Retinal fundus photograph:
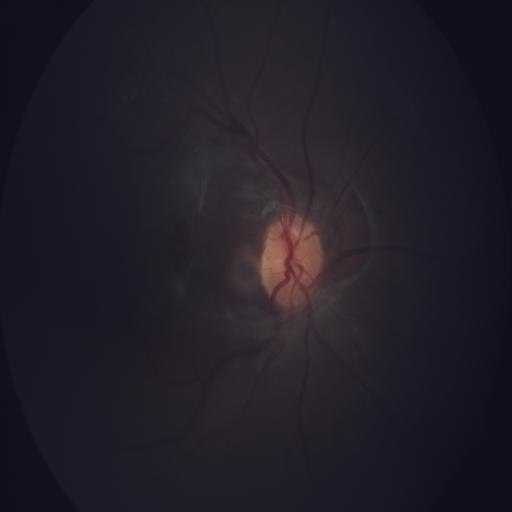 Findings consistent with silicone oil-filled eye.